CFP · image size 2212x1659 · 45° field of view.
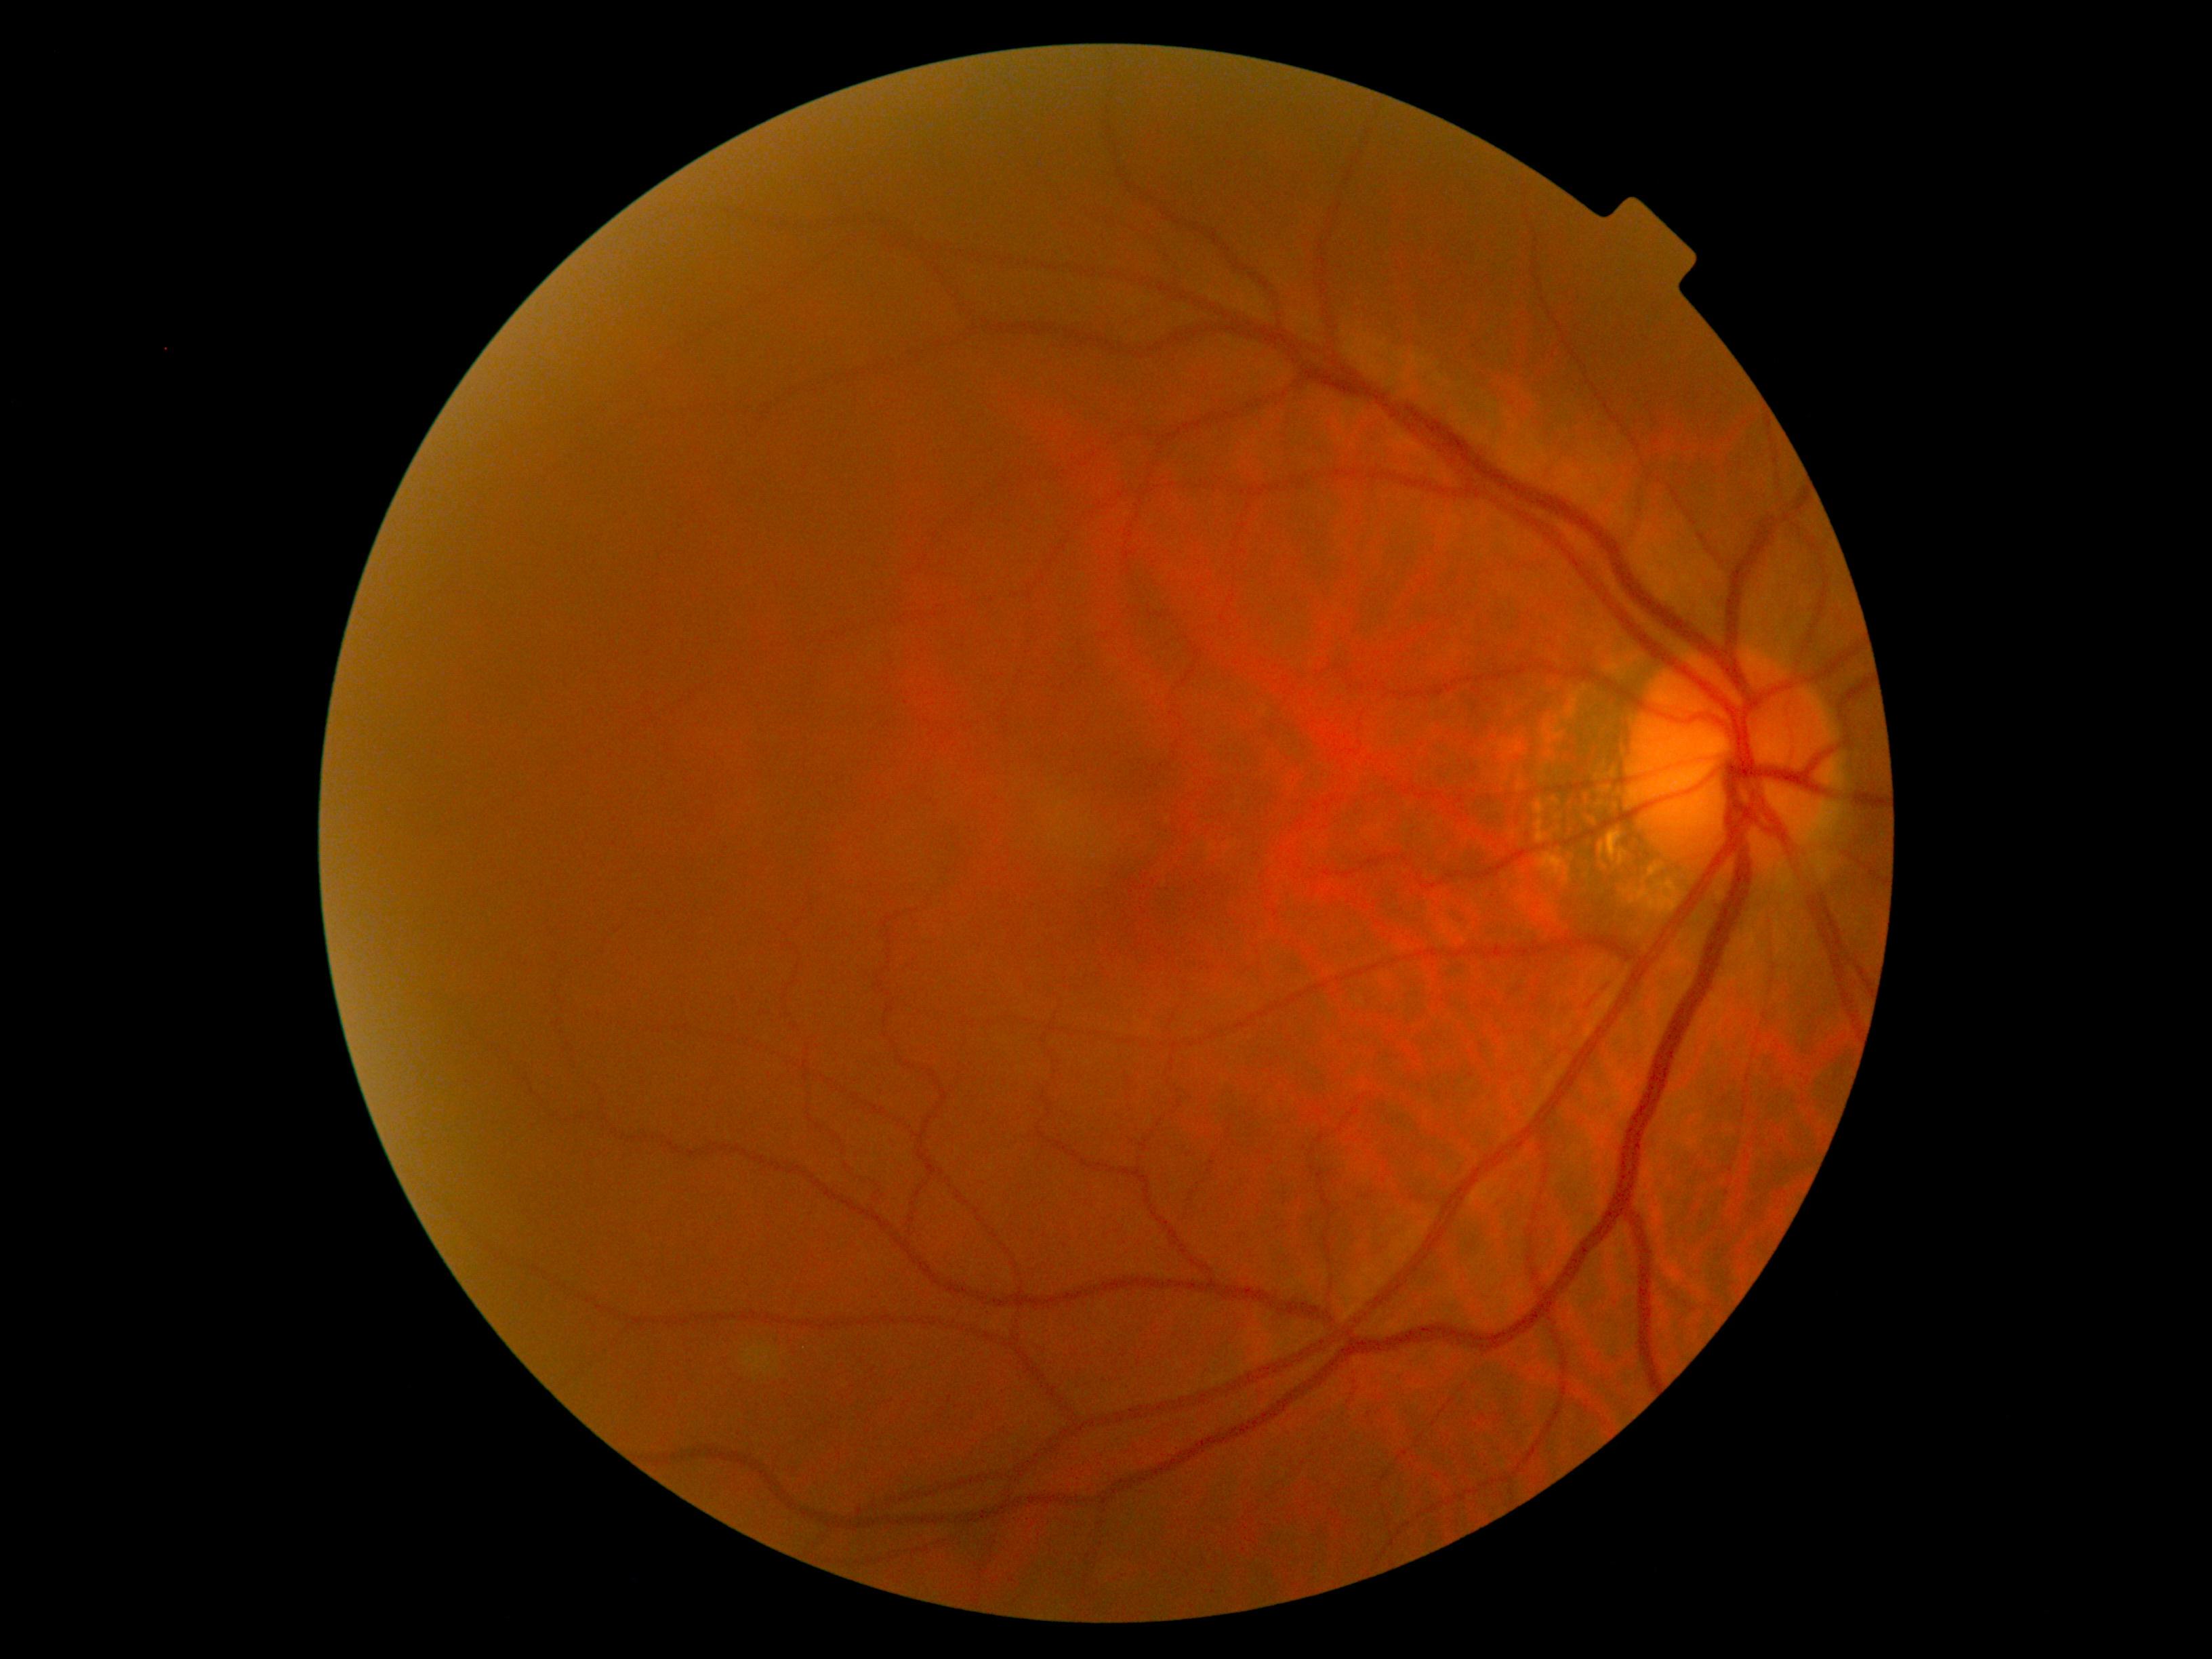
DR severity is grade 0.
No signs of diabetic retinopathy.